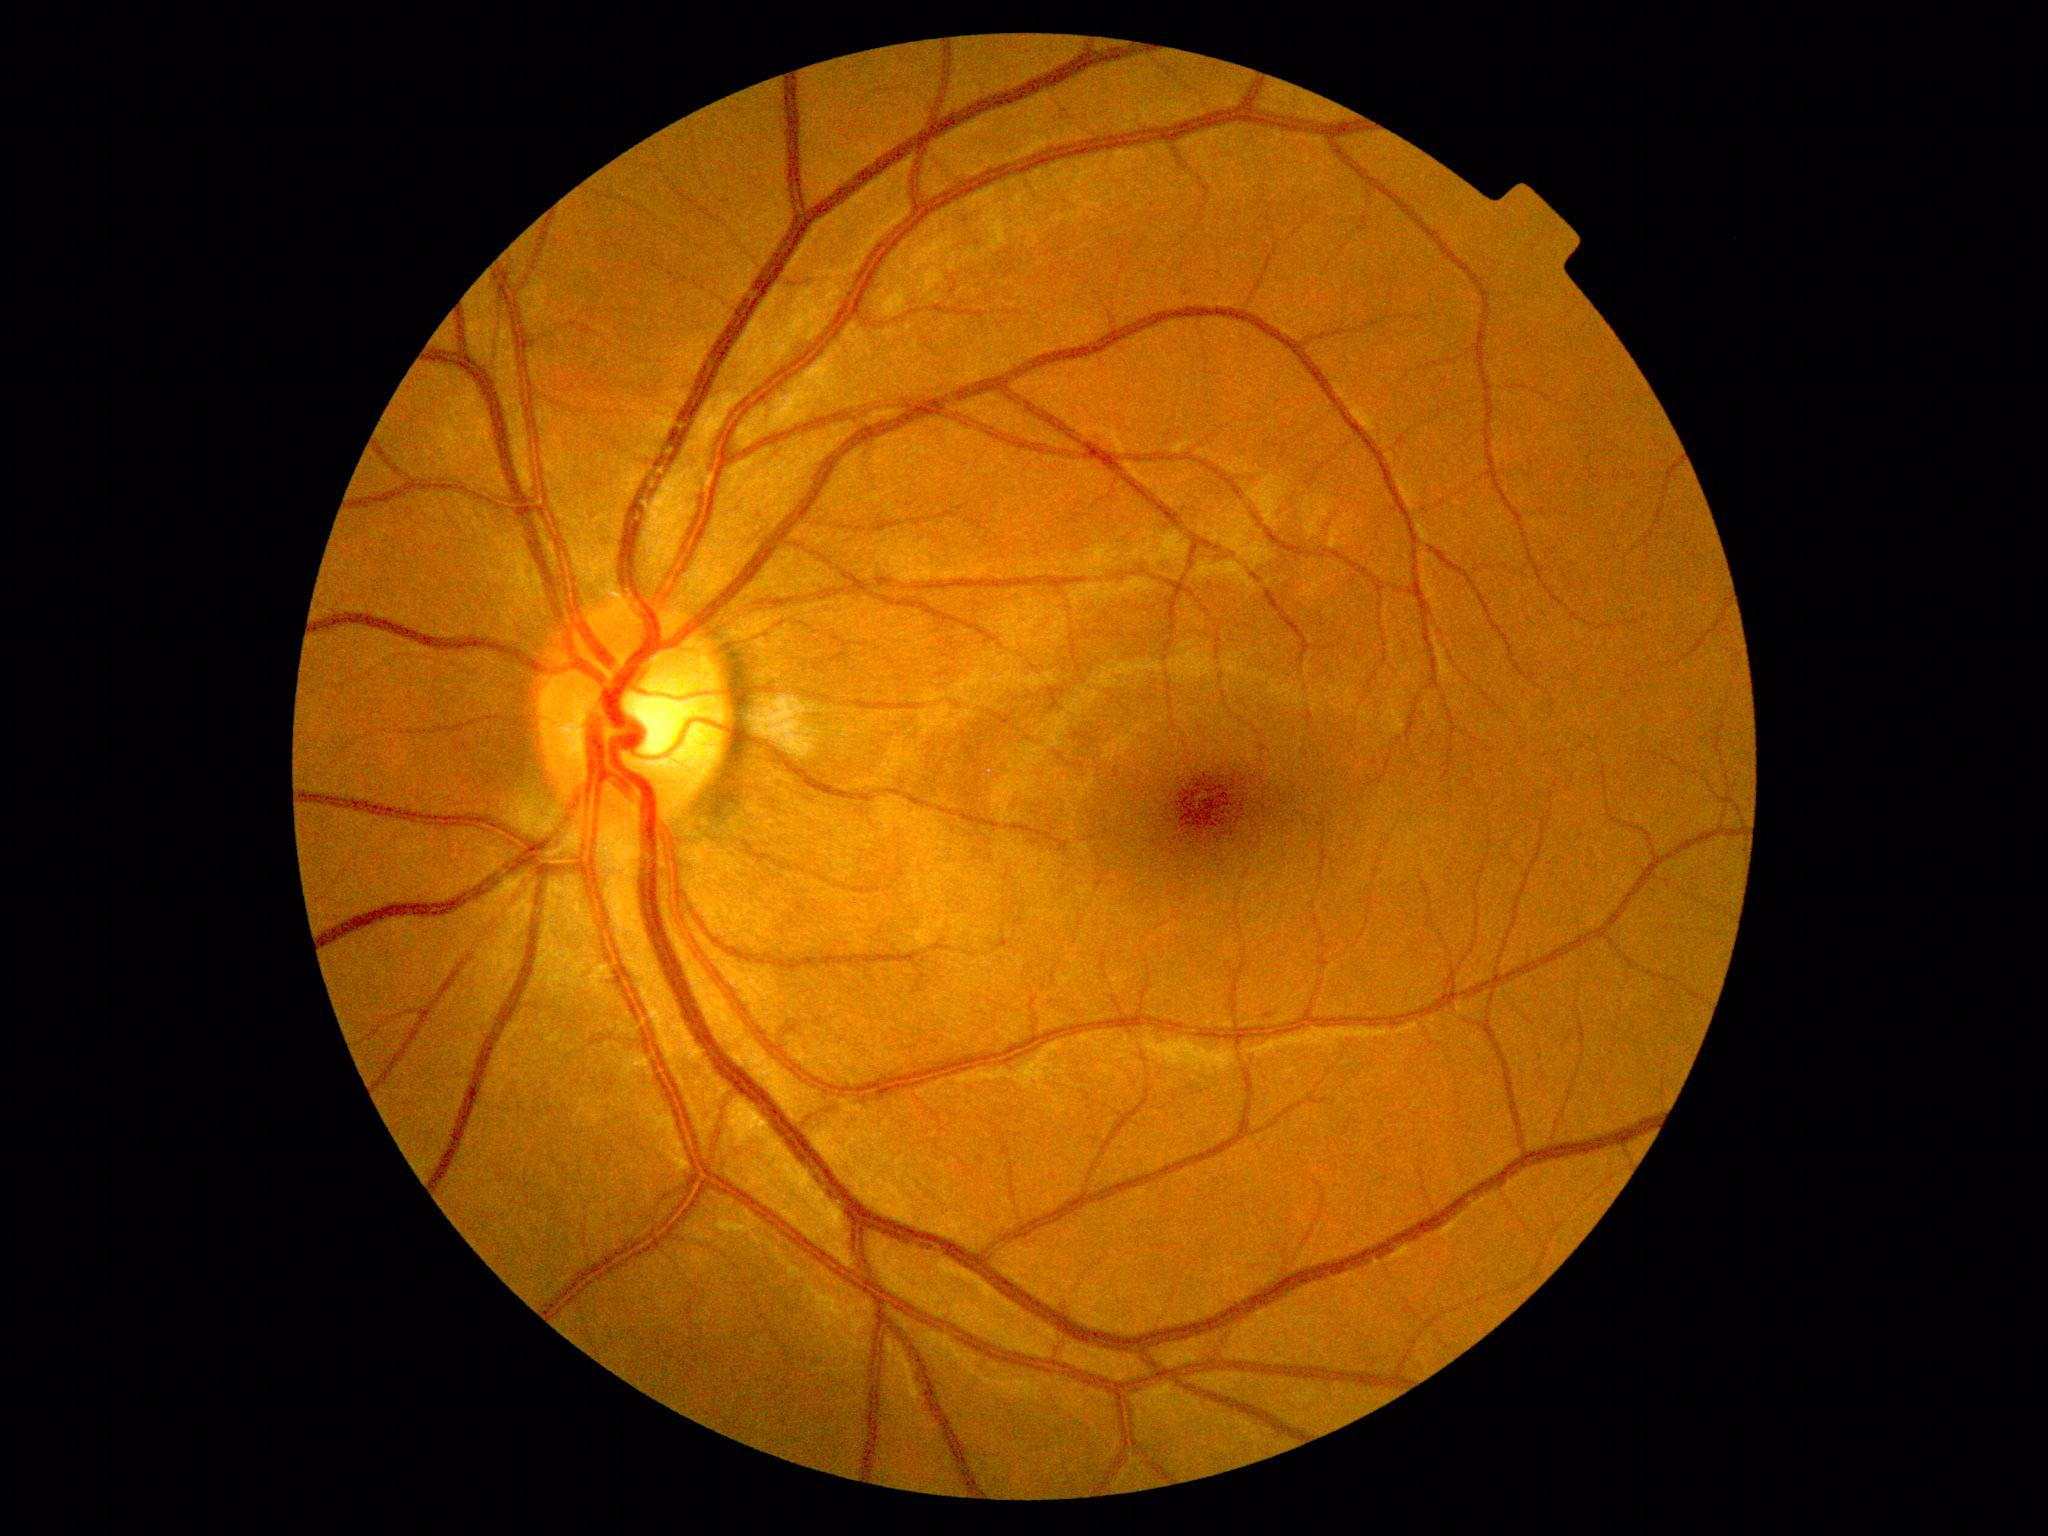 diabetic retinopathy: mild NPDR (grade 1).